Image size 1659x2212.
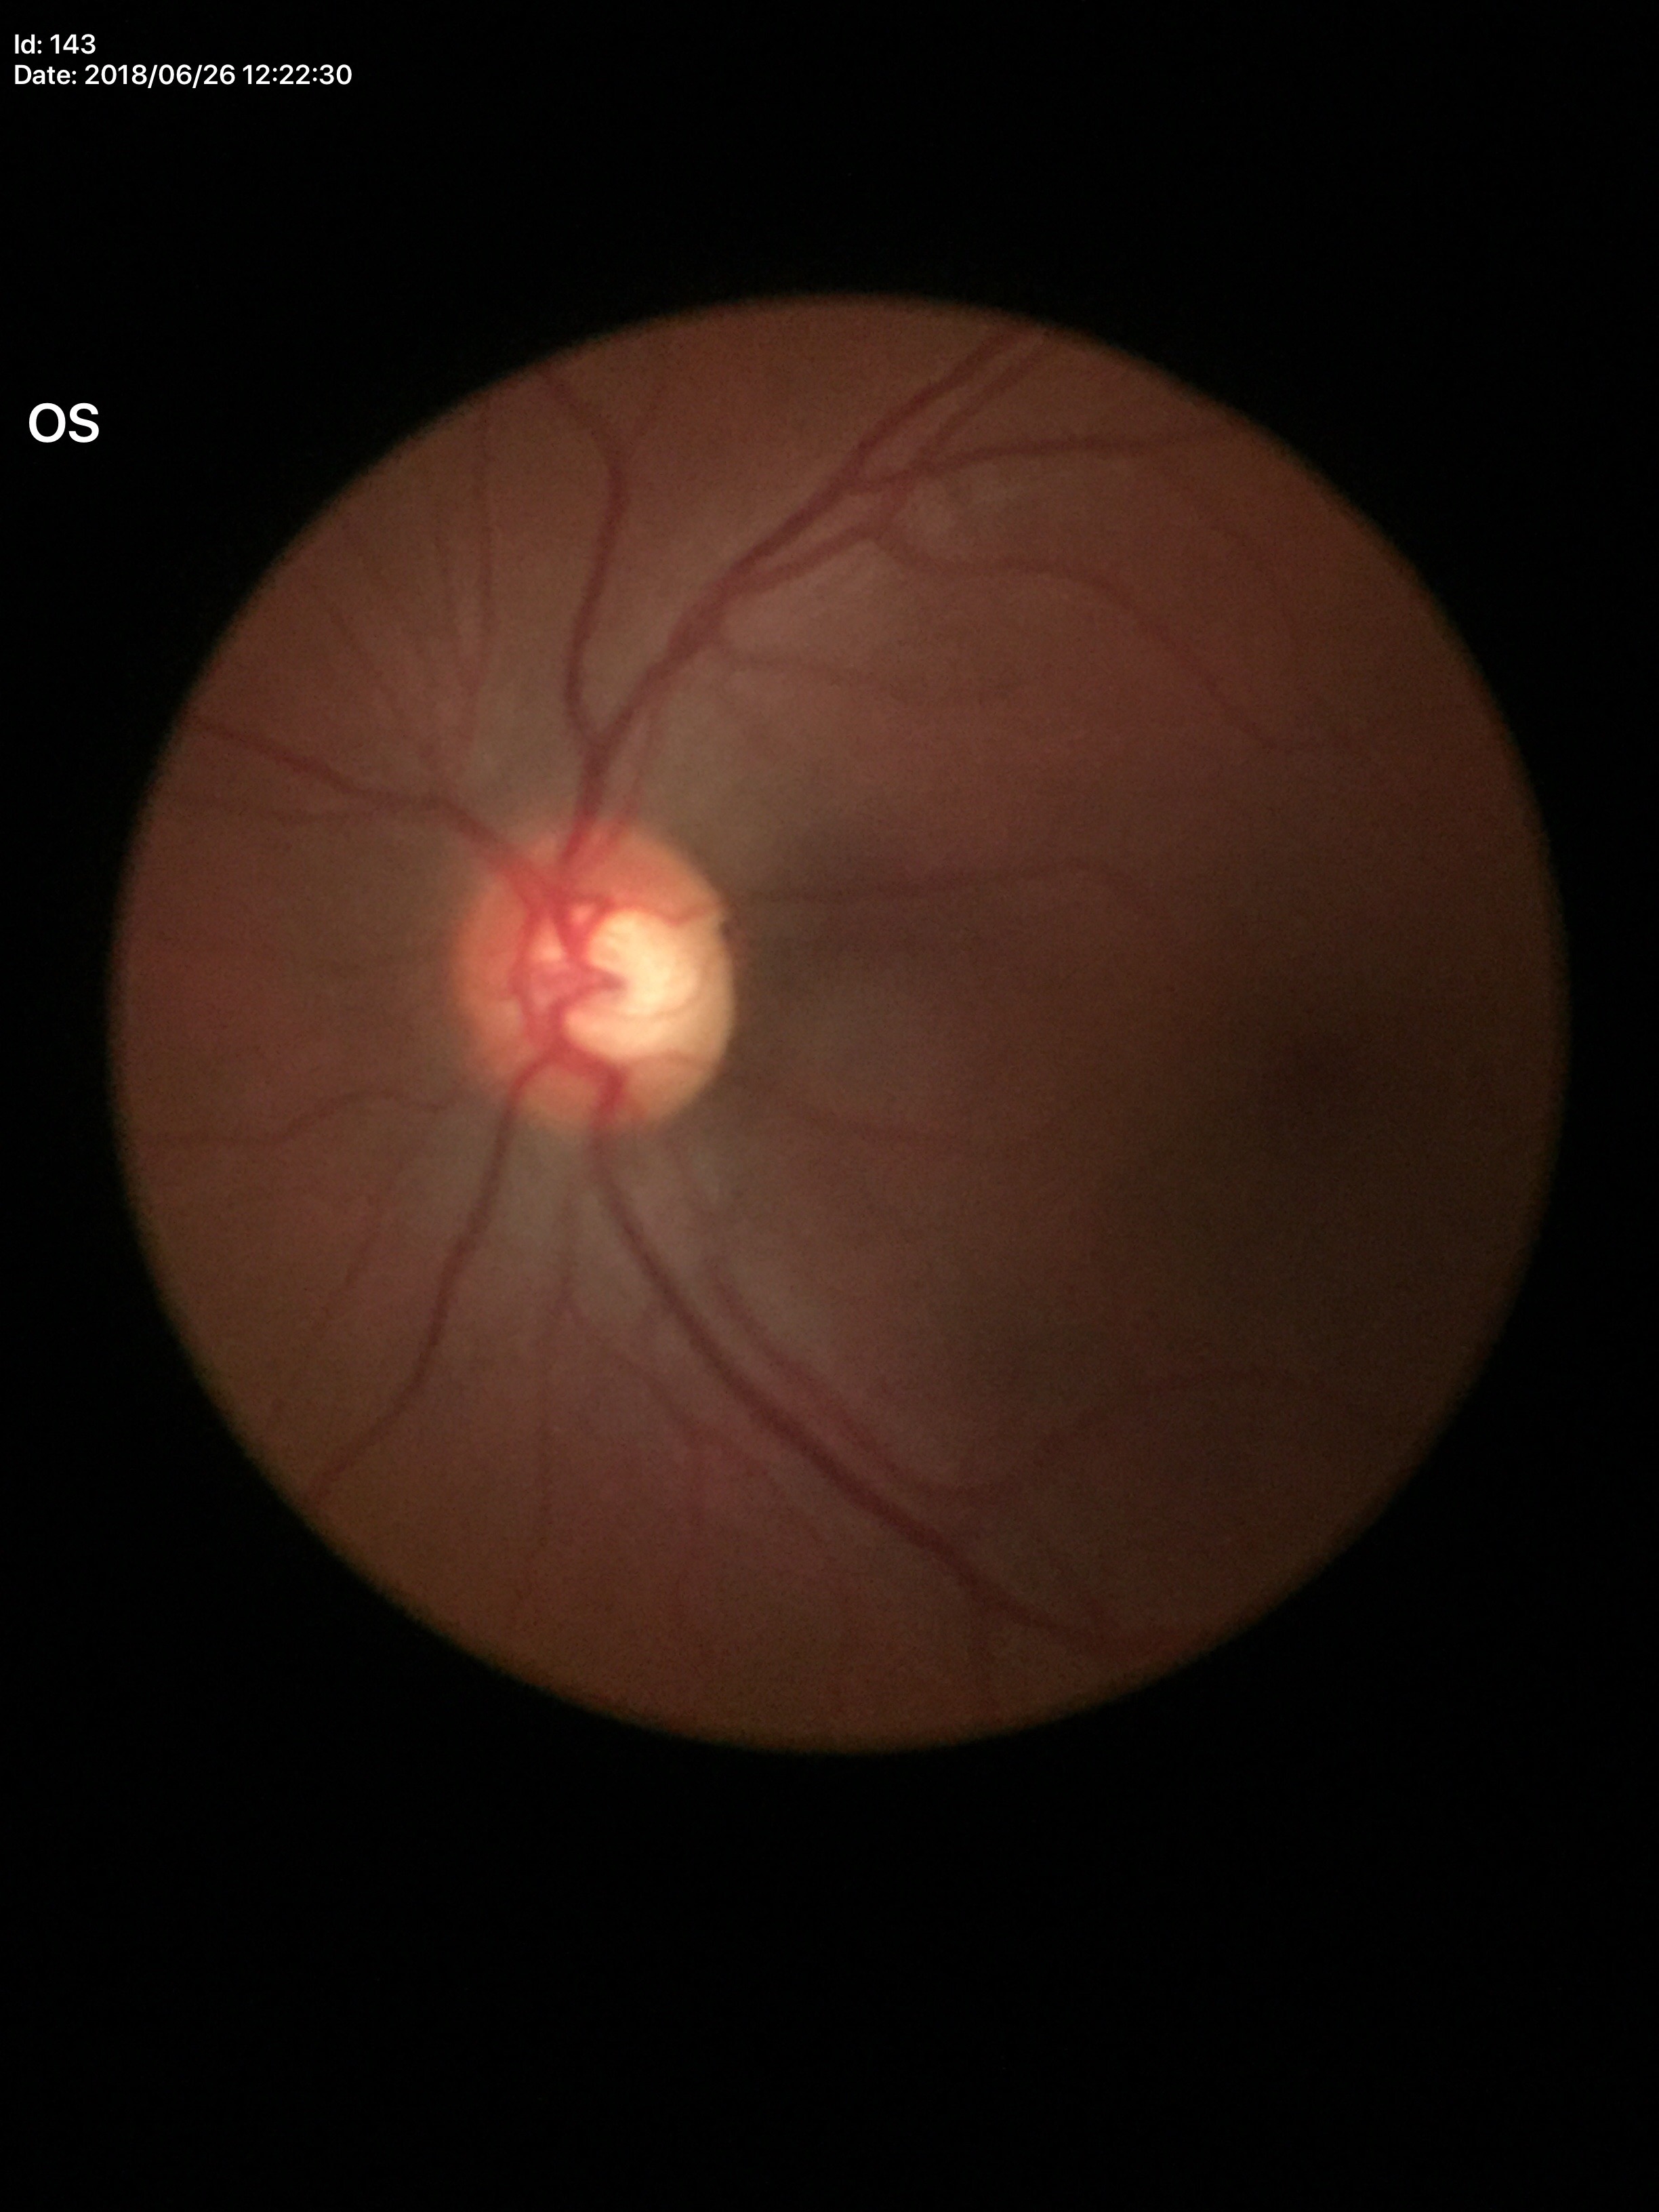
Suspicious for glaucoma. Vertical CDR (VCDR): 0.60.